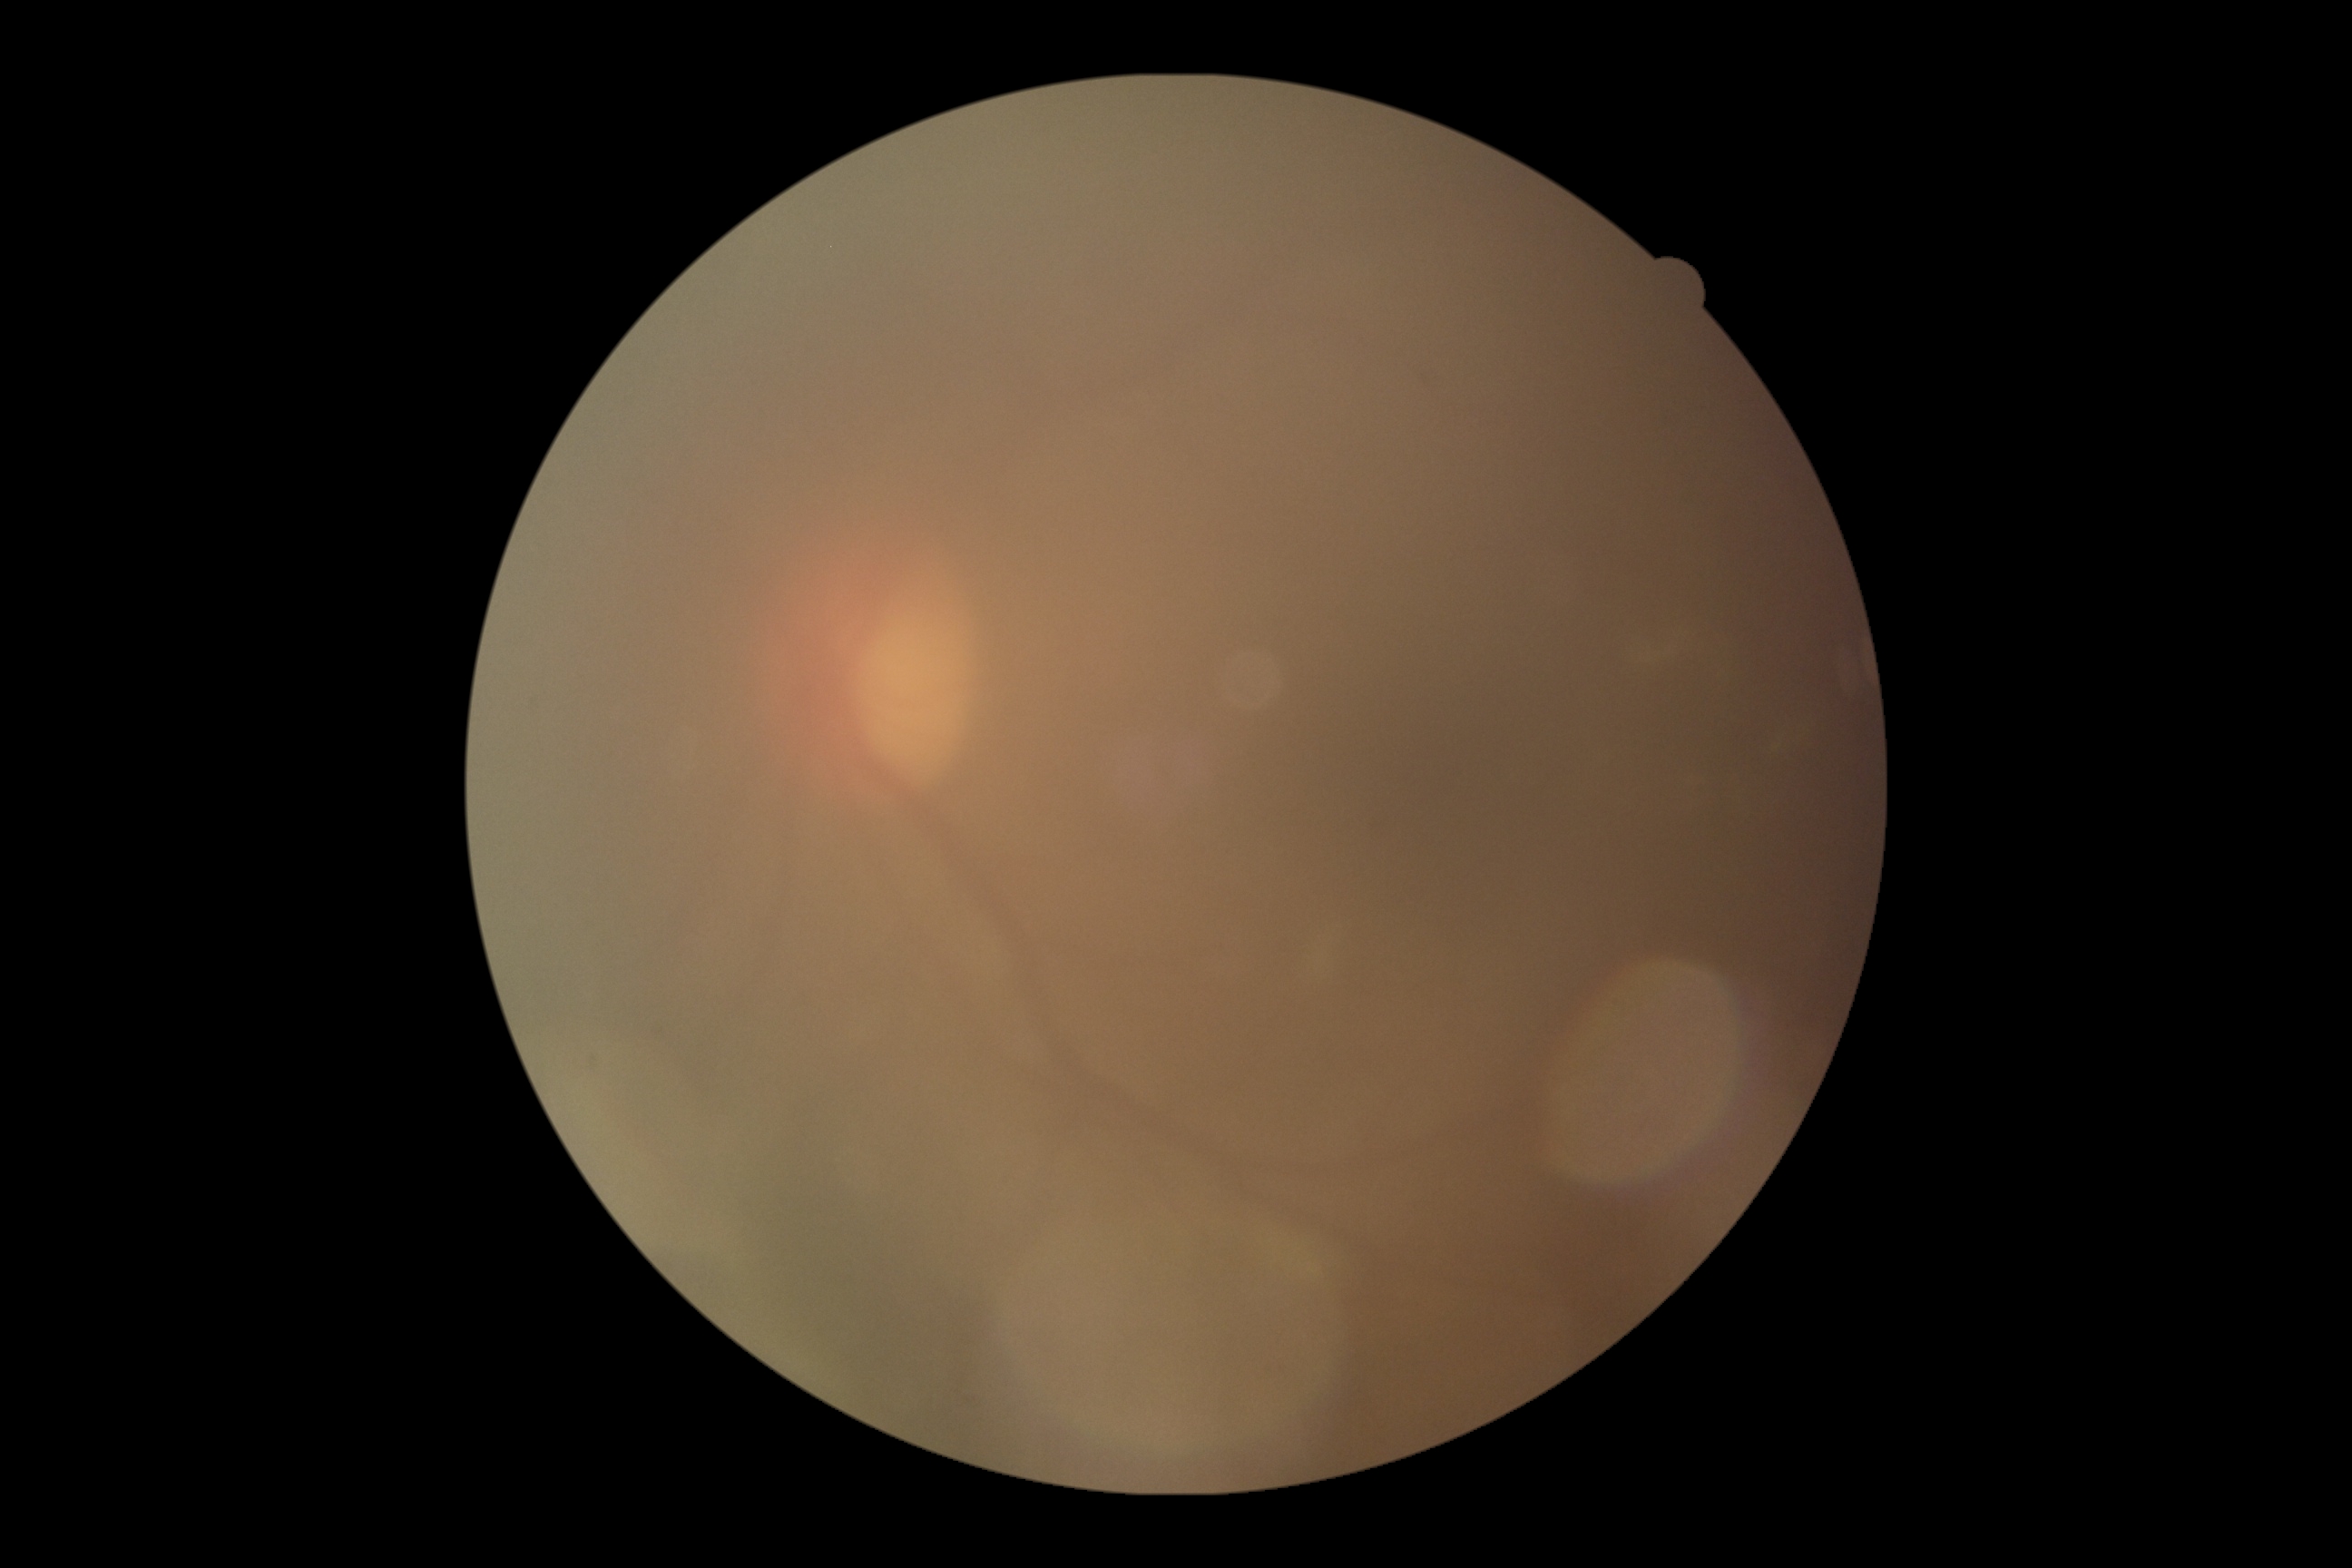 DR grade = ungradable due to poor image quality; image quality = insufficient.